Color fundus image · 2184 x 1690 pixels:
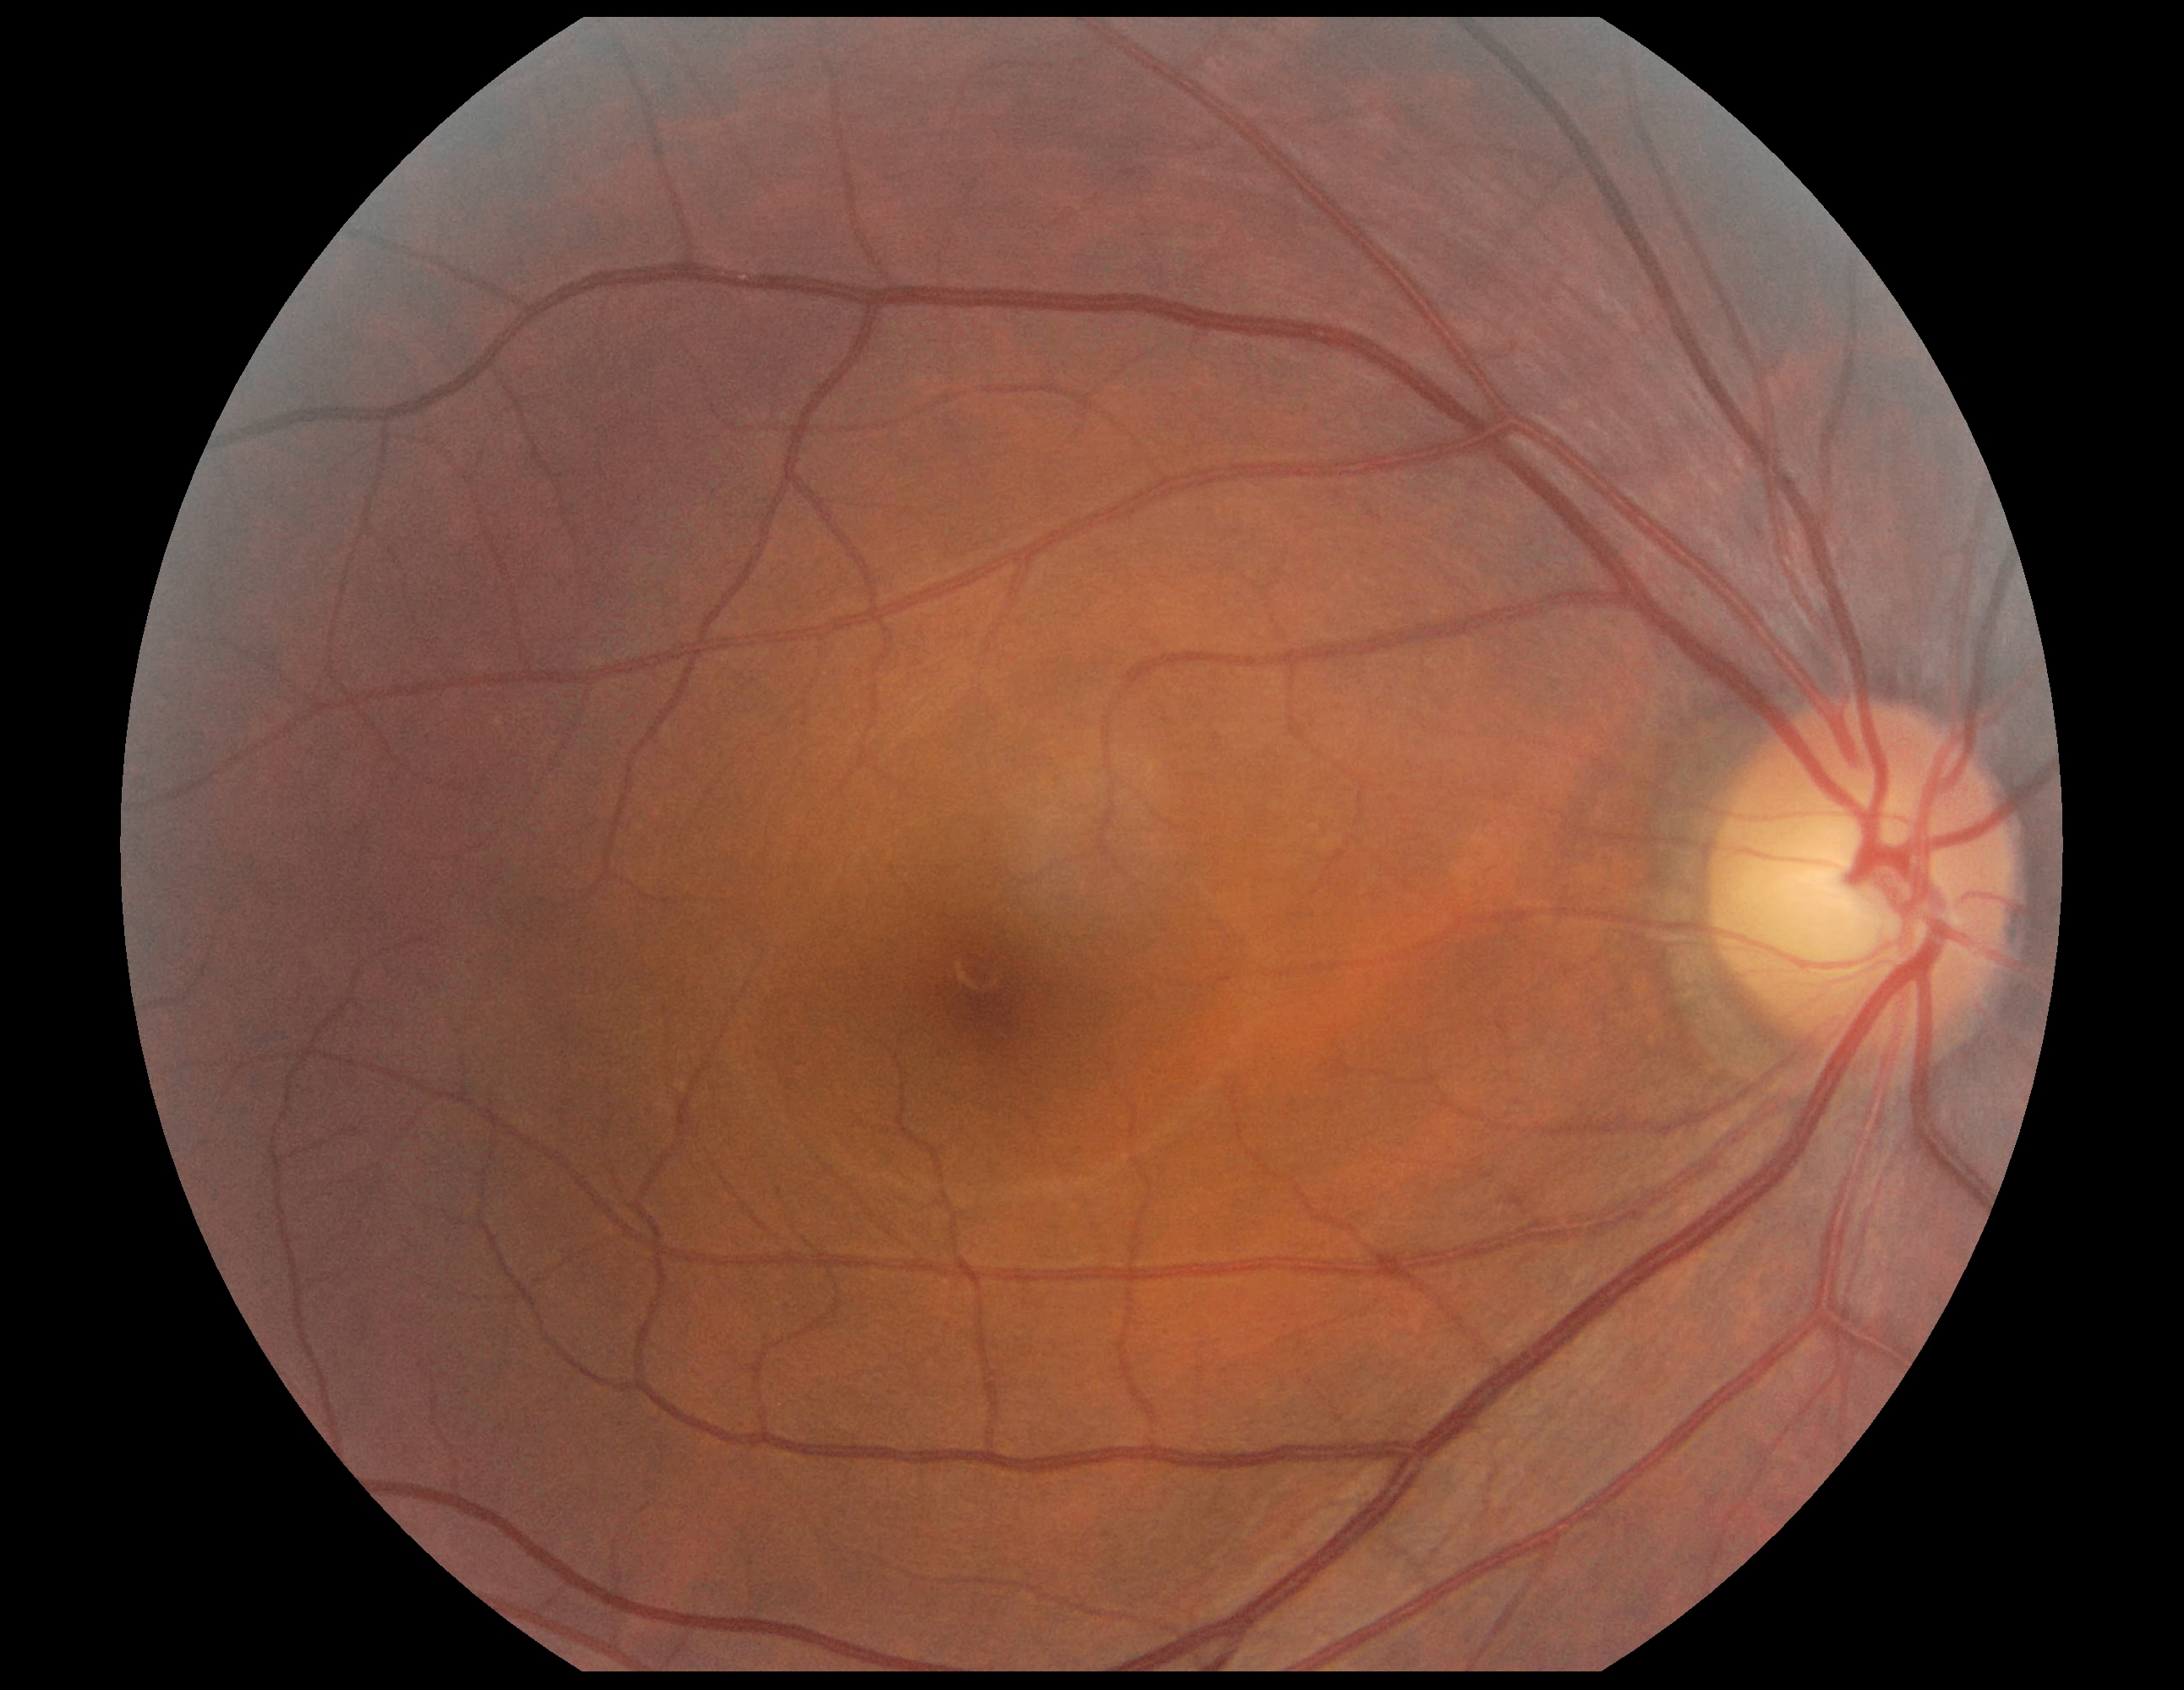
– diabetic retinopathy — grade 0 (no apparent retinopathy) — no visible signs of diabetic retinopathy